Retinal fundus photograph.
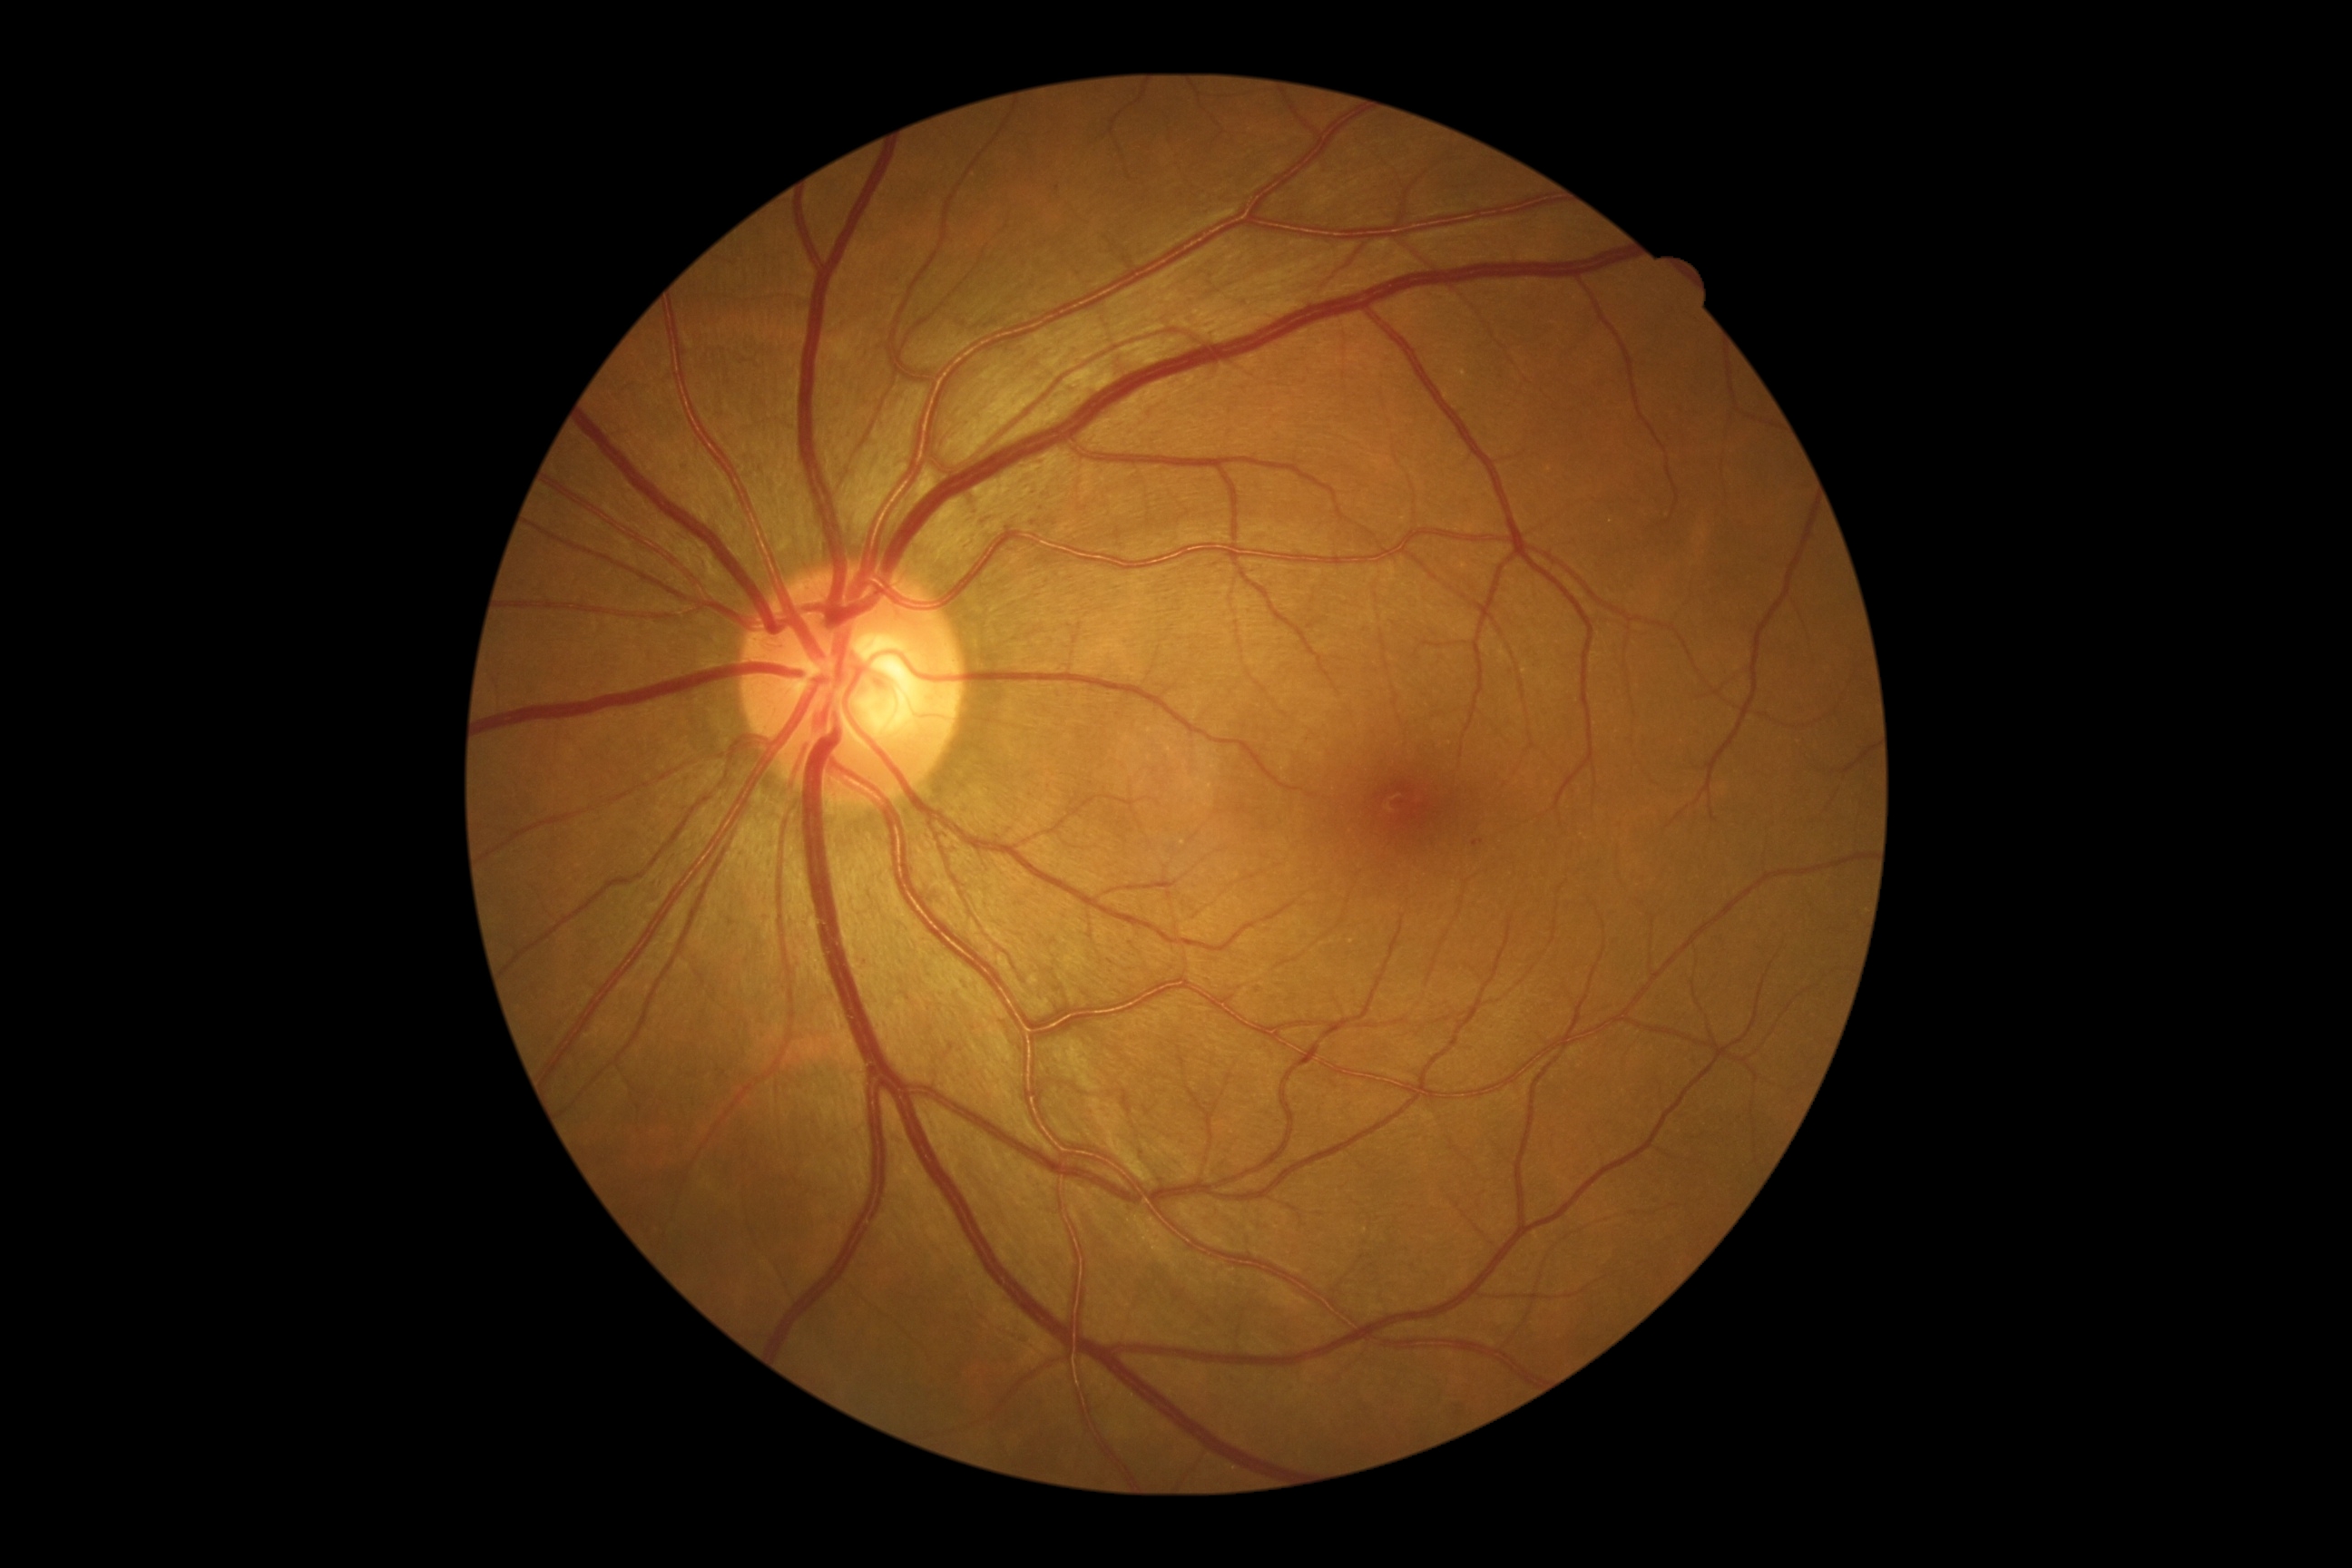

retinopathy=grade 1 (mild NPDR) — presence of microaneurysms only.